Non-mydriatic acquisition.
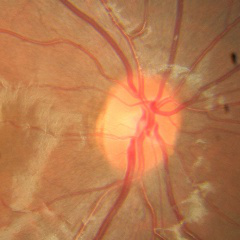 Optic disc appearance consistent with no glaucomatous changes.